1240 x 1240 pixels. Pediatric retinal photograph (wide-field). Acquired on the Phoenix ICON
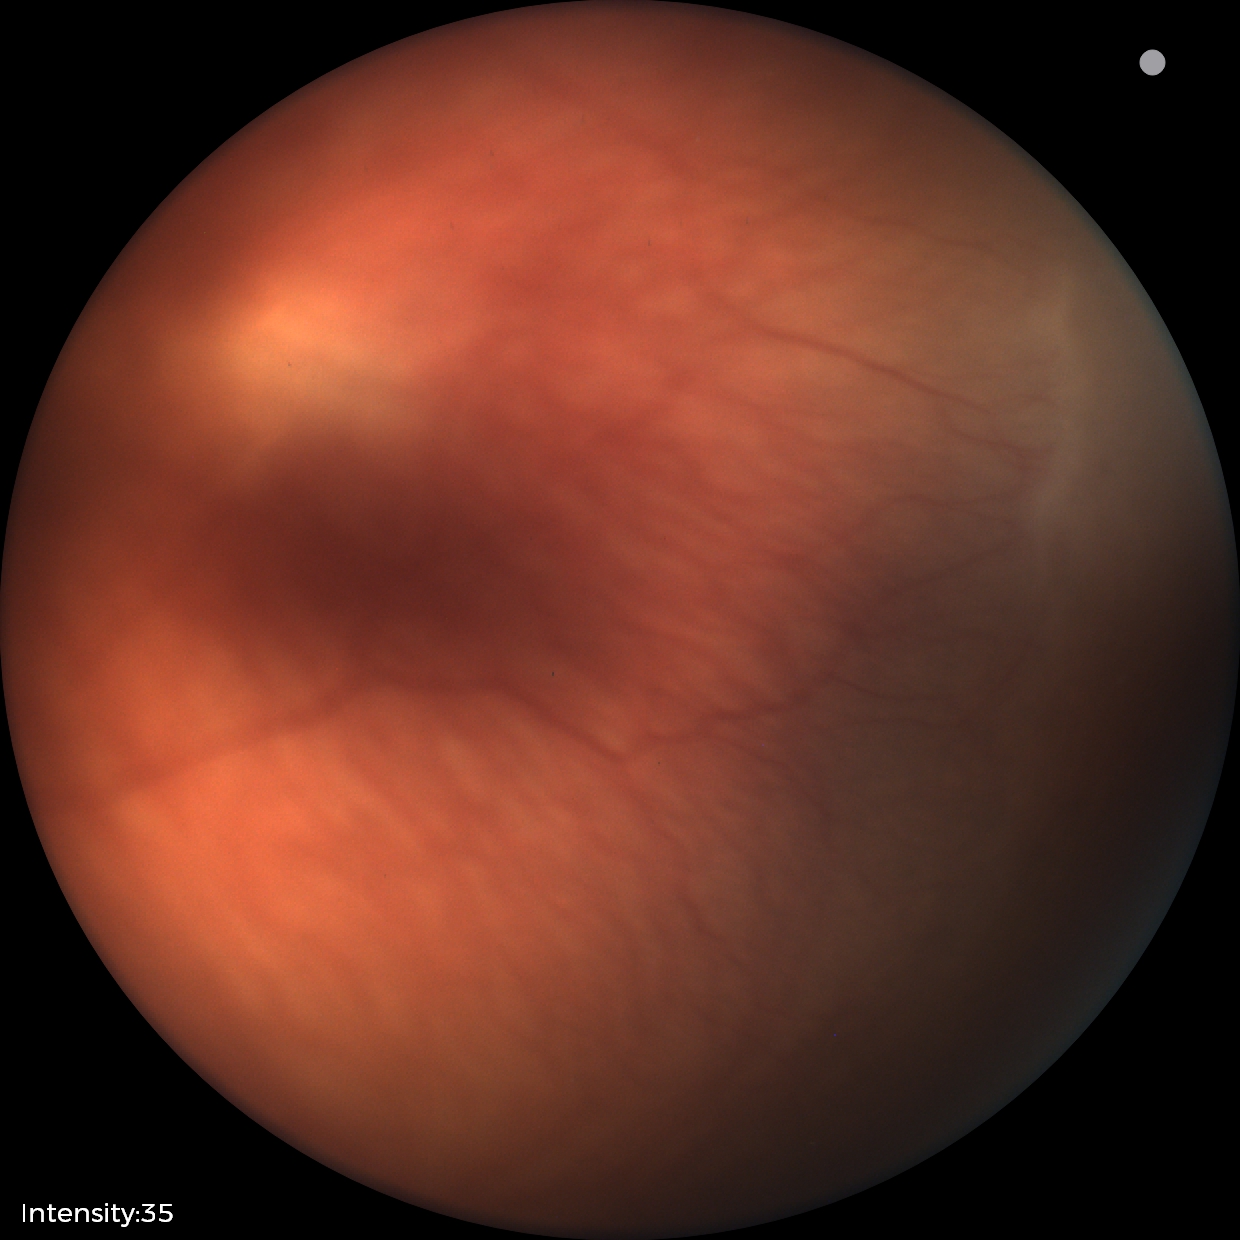

Impression: no plus disease; ROP stage 2.